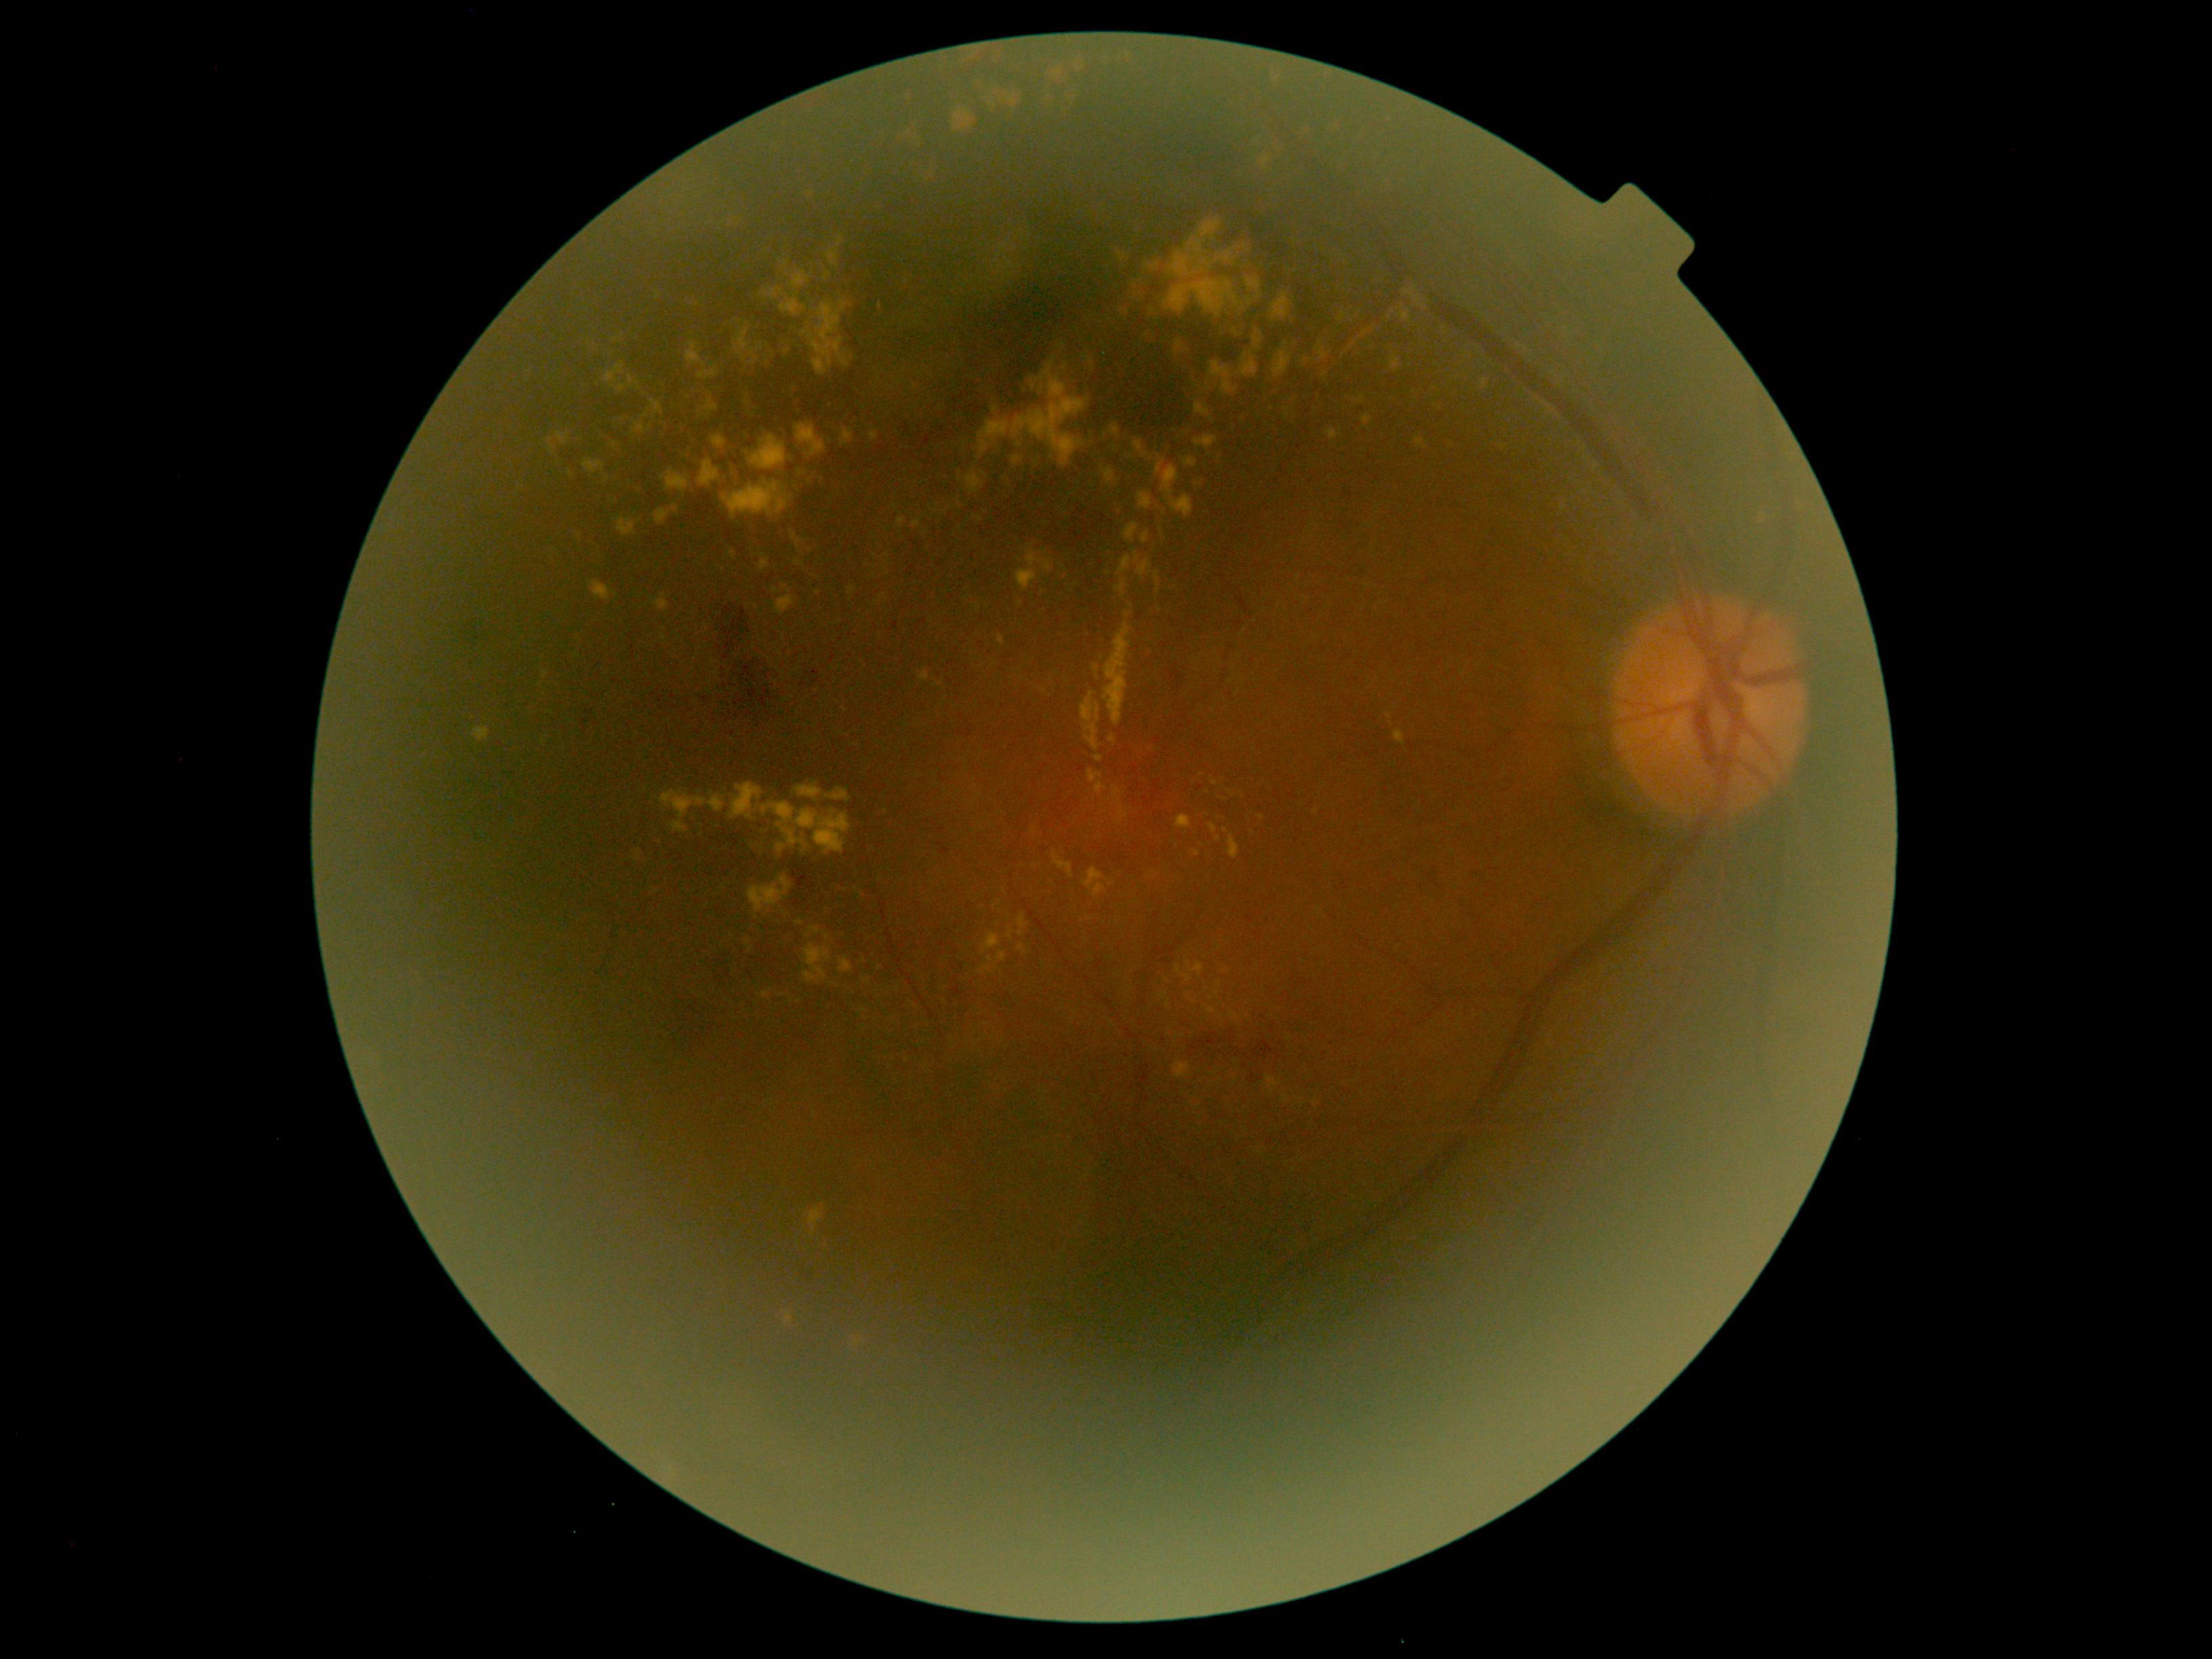 DR grade is moderate NPDR (2)
Representative lesions:
EXs (subset) = 1328/428/1338/441 | 810/926/822/936 | 1138/491/1151/510 | 1031/380/1035/390 | 750/359/758/367 | 1385/712/1391/720 | 1081/692/1101/752 | 1273/350/1292/379 | 1317/348/1332/361 | 730/783/852/853 | 588/582/611/601 | 869/433/880/441 | 1299/129/1318/147
Smaller EXs around 1130/606 | 1208/792 | 1020/445 | 886/569 | 1109/573 | 1127/312 | 1201/774